1240x1240px; wide-field fundus photograph from neonatal ROP screening; captured with the Phoenix ICON (100° field of view)
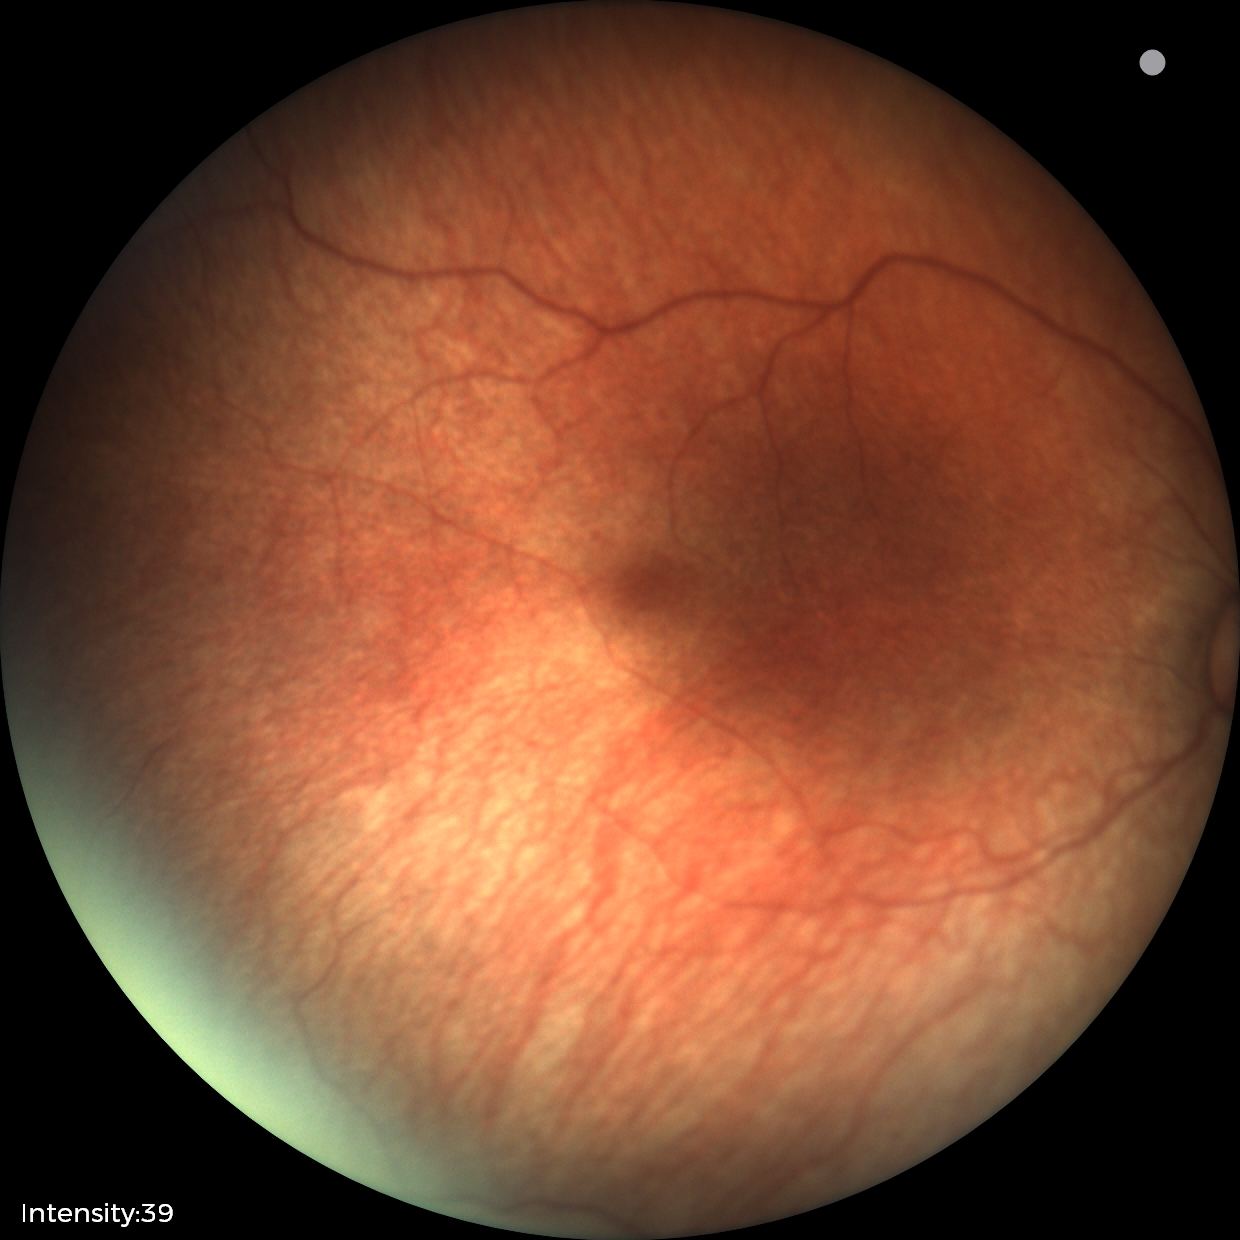

Normal screening examination.